848x848: 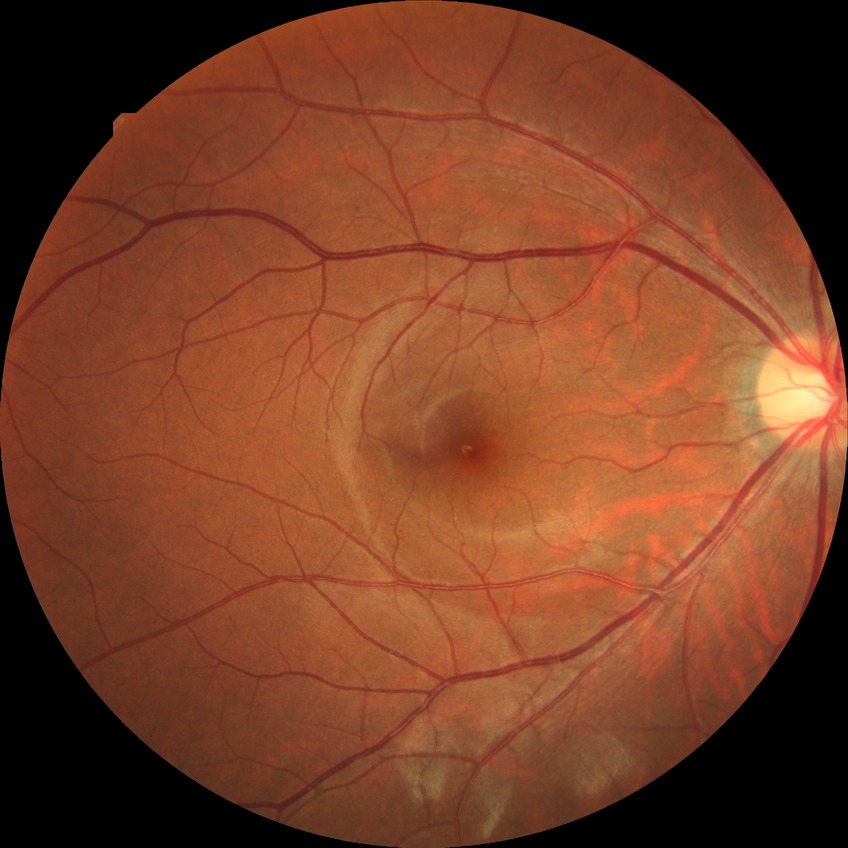

DR class@non-proliferative diabetic retinopathy, diabetic retinopathy (DR)@simple diabetic retinopathy (SDR).